45 degree fundus photograph. Nonmydriatic
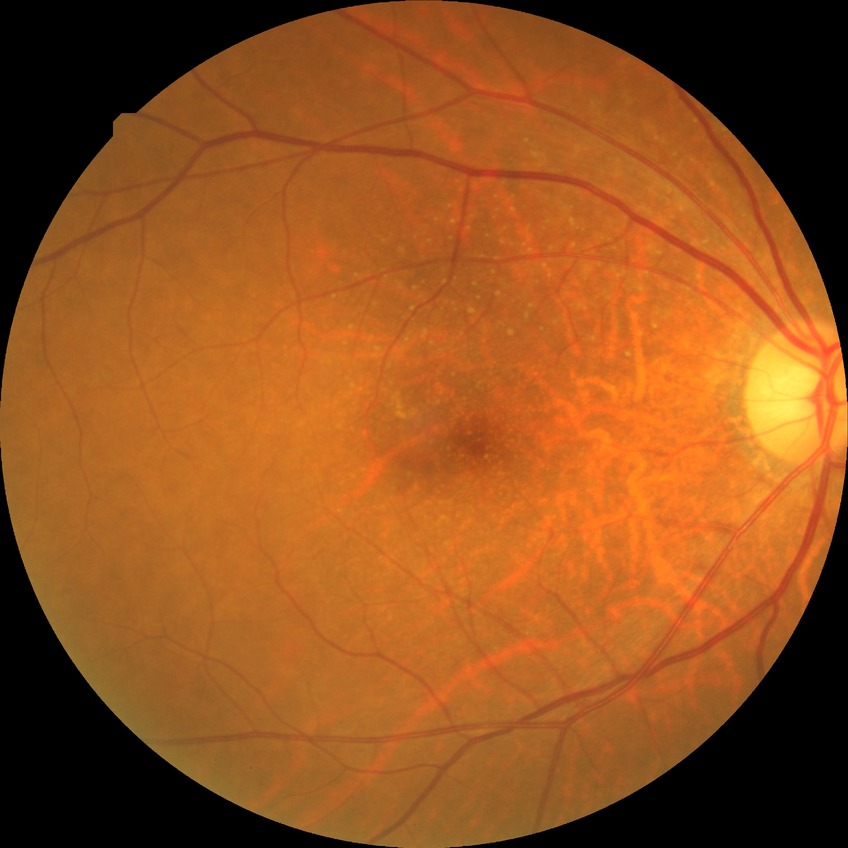 Disease class: non-proliferative diabetic retinopathy.
DR stage is SDR.